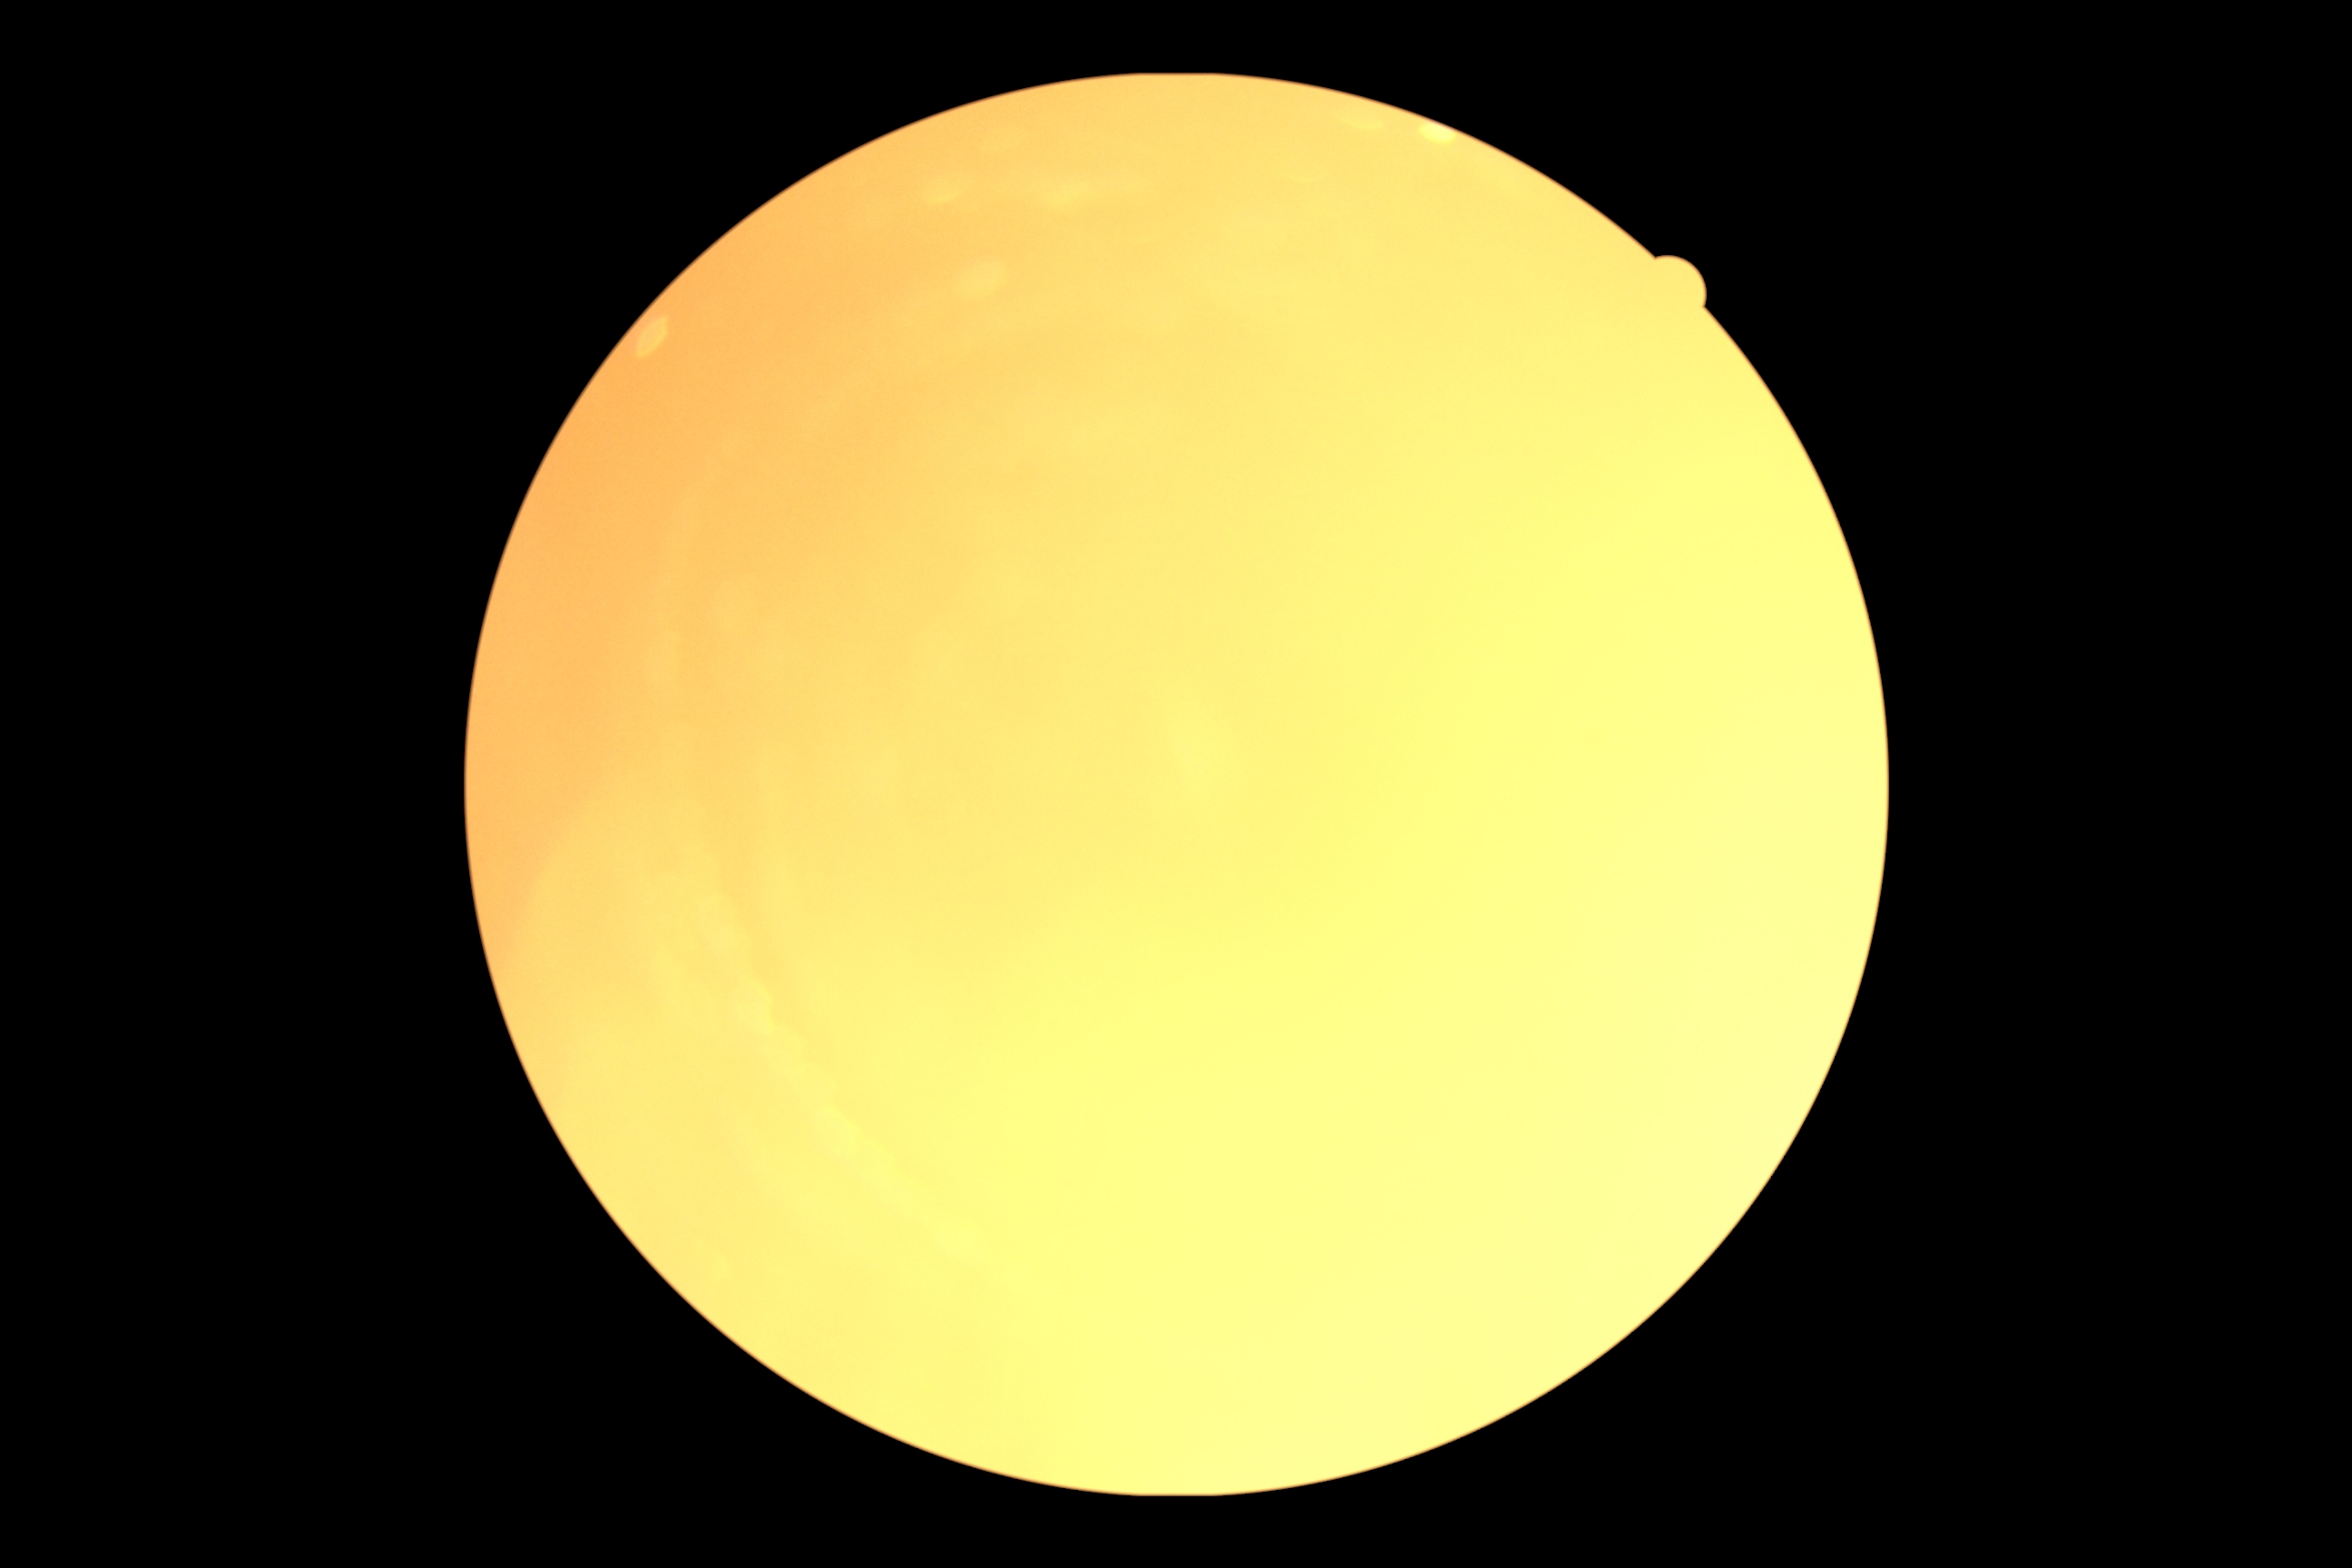
Ungradable image — DR severity cannot be determined.
DR grade: ungradable due to poor image quality.